Infant wide-field fundus photograph · 1240x1240px · acquired on the Phoenix ICON
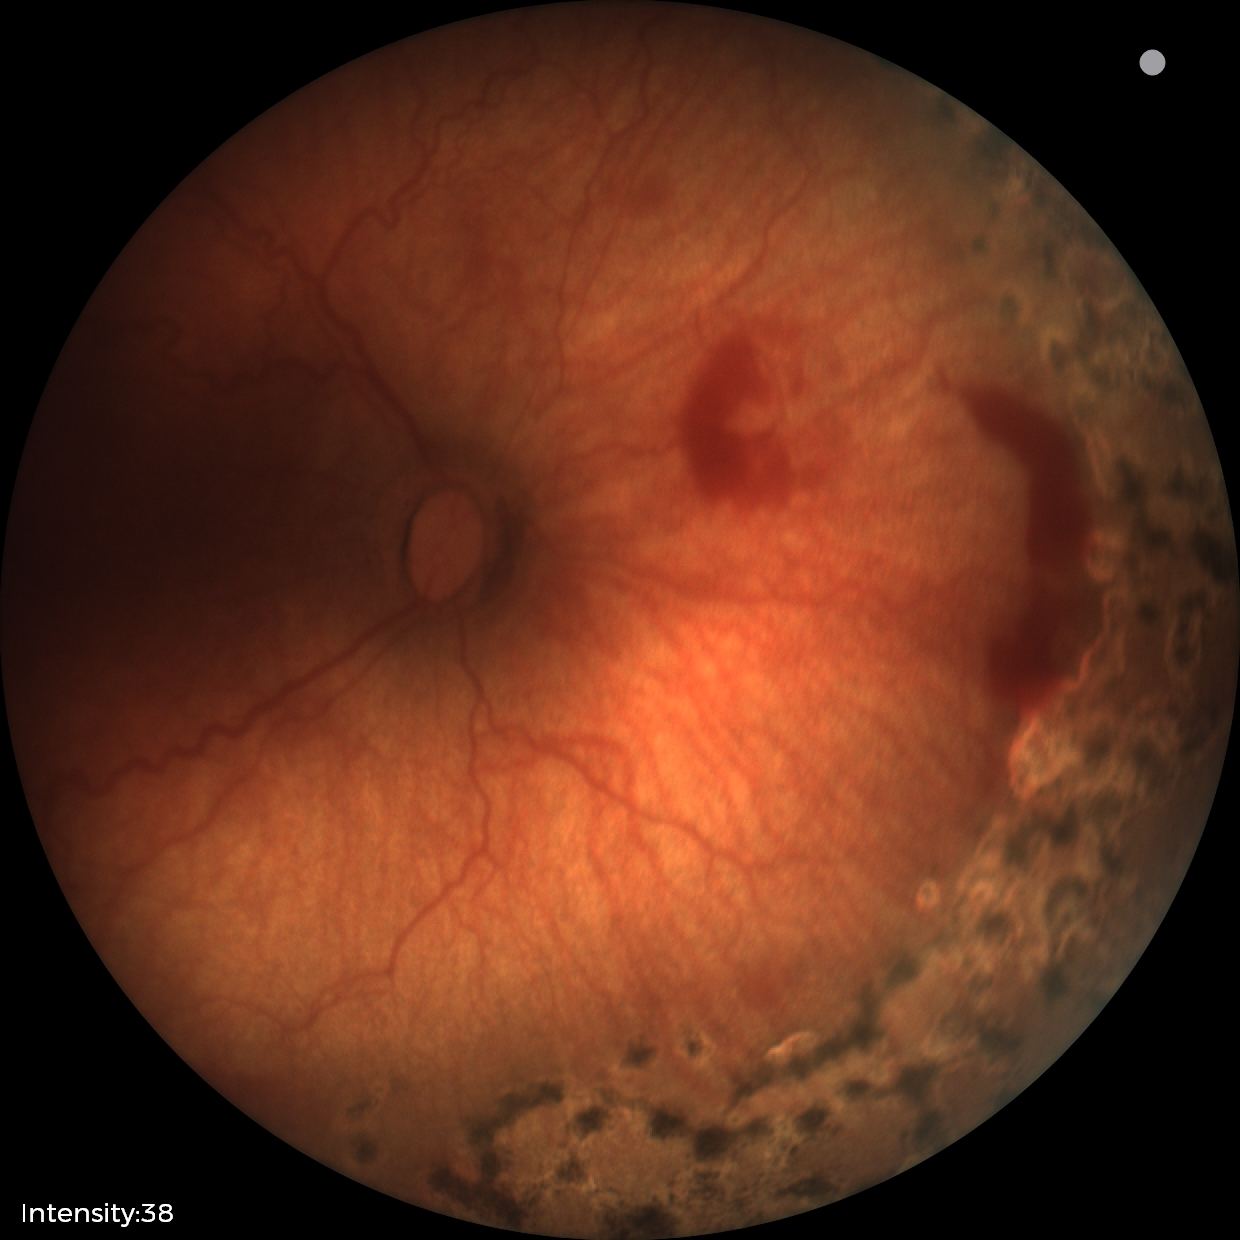

Screening diagnosis = status post retinopathy of prematurity; plus form = absent.